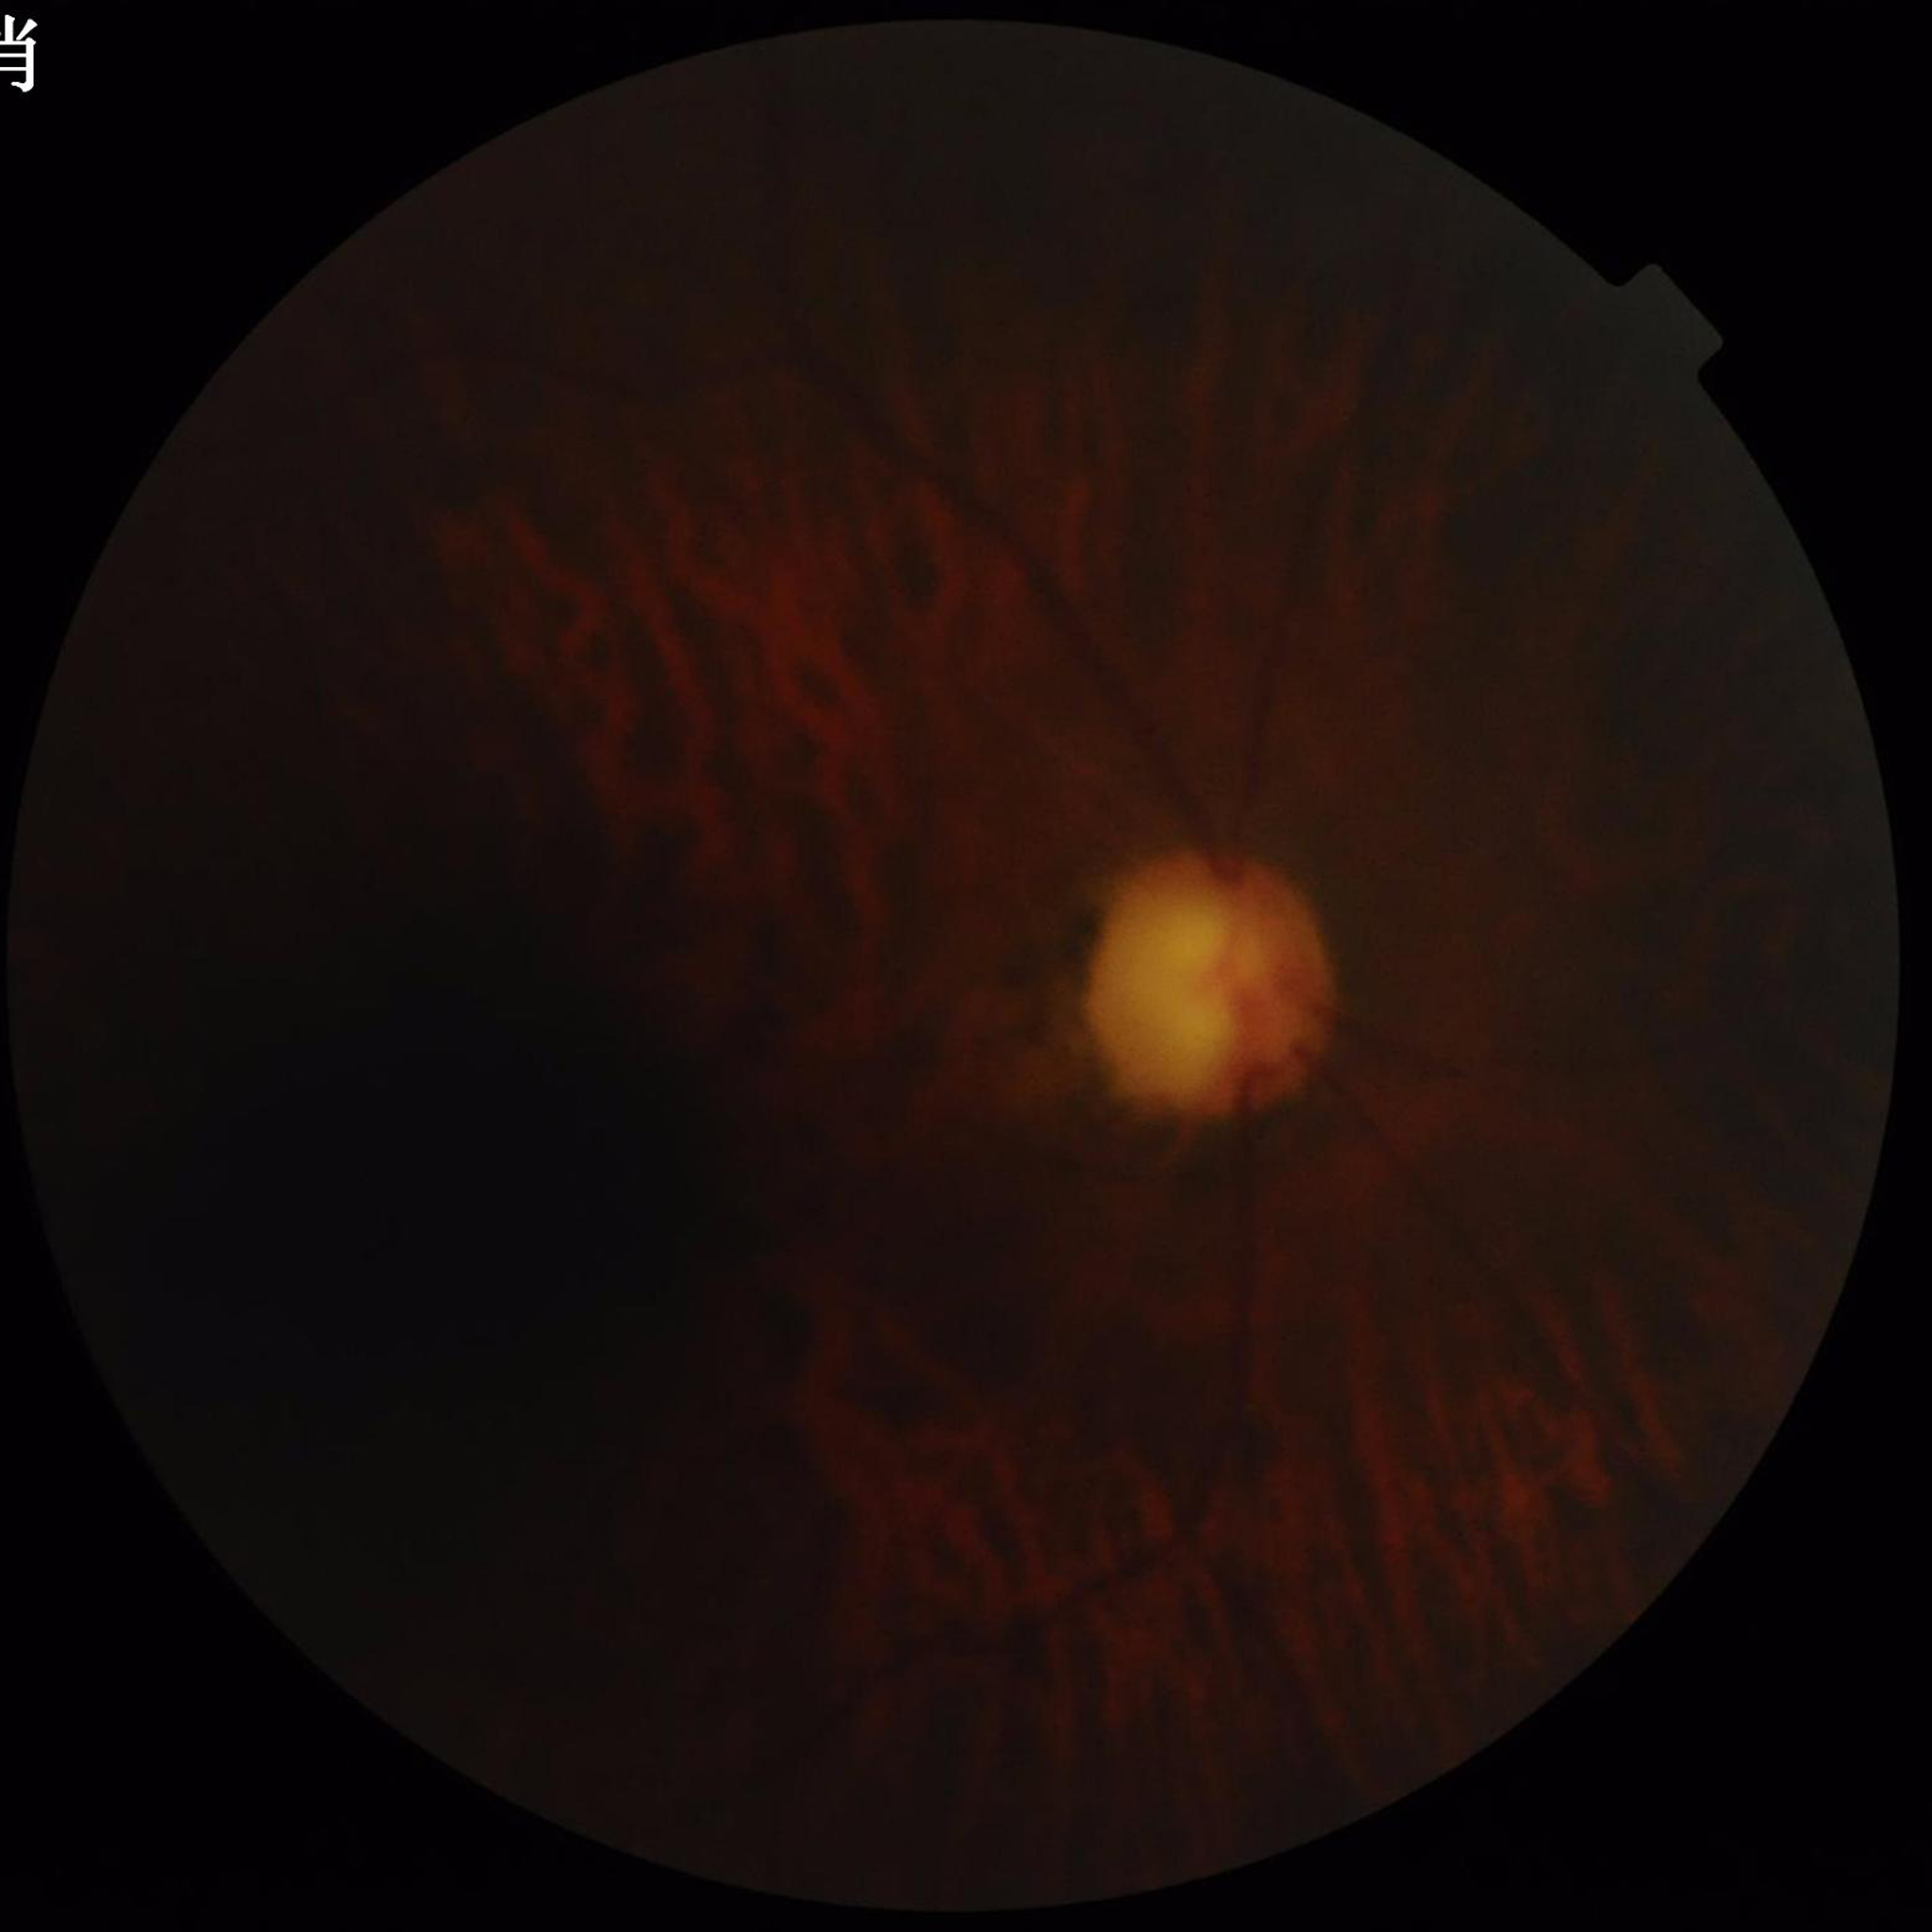
Quality assessment = issues noted — blur, low contrast, illumination/color distortion; Disease class = glaucoma.